240x240px
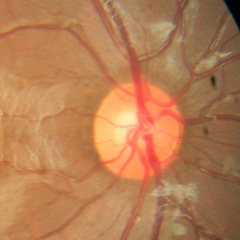 Color fundus photograph showing no glaucomatous changes.